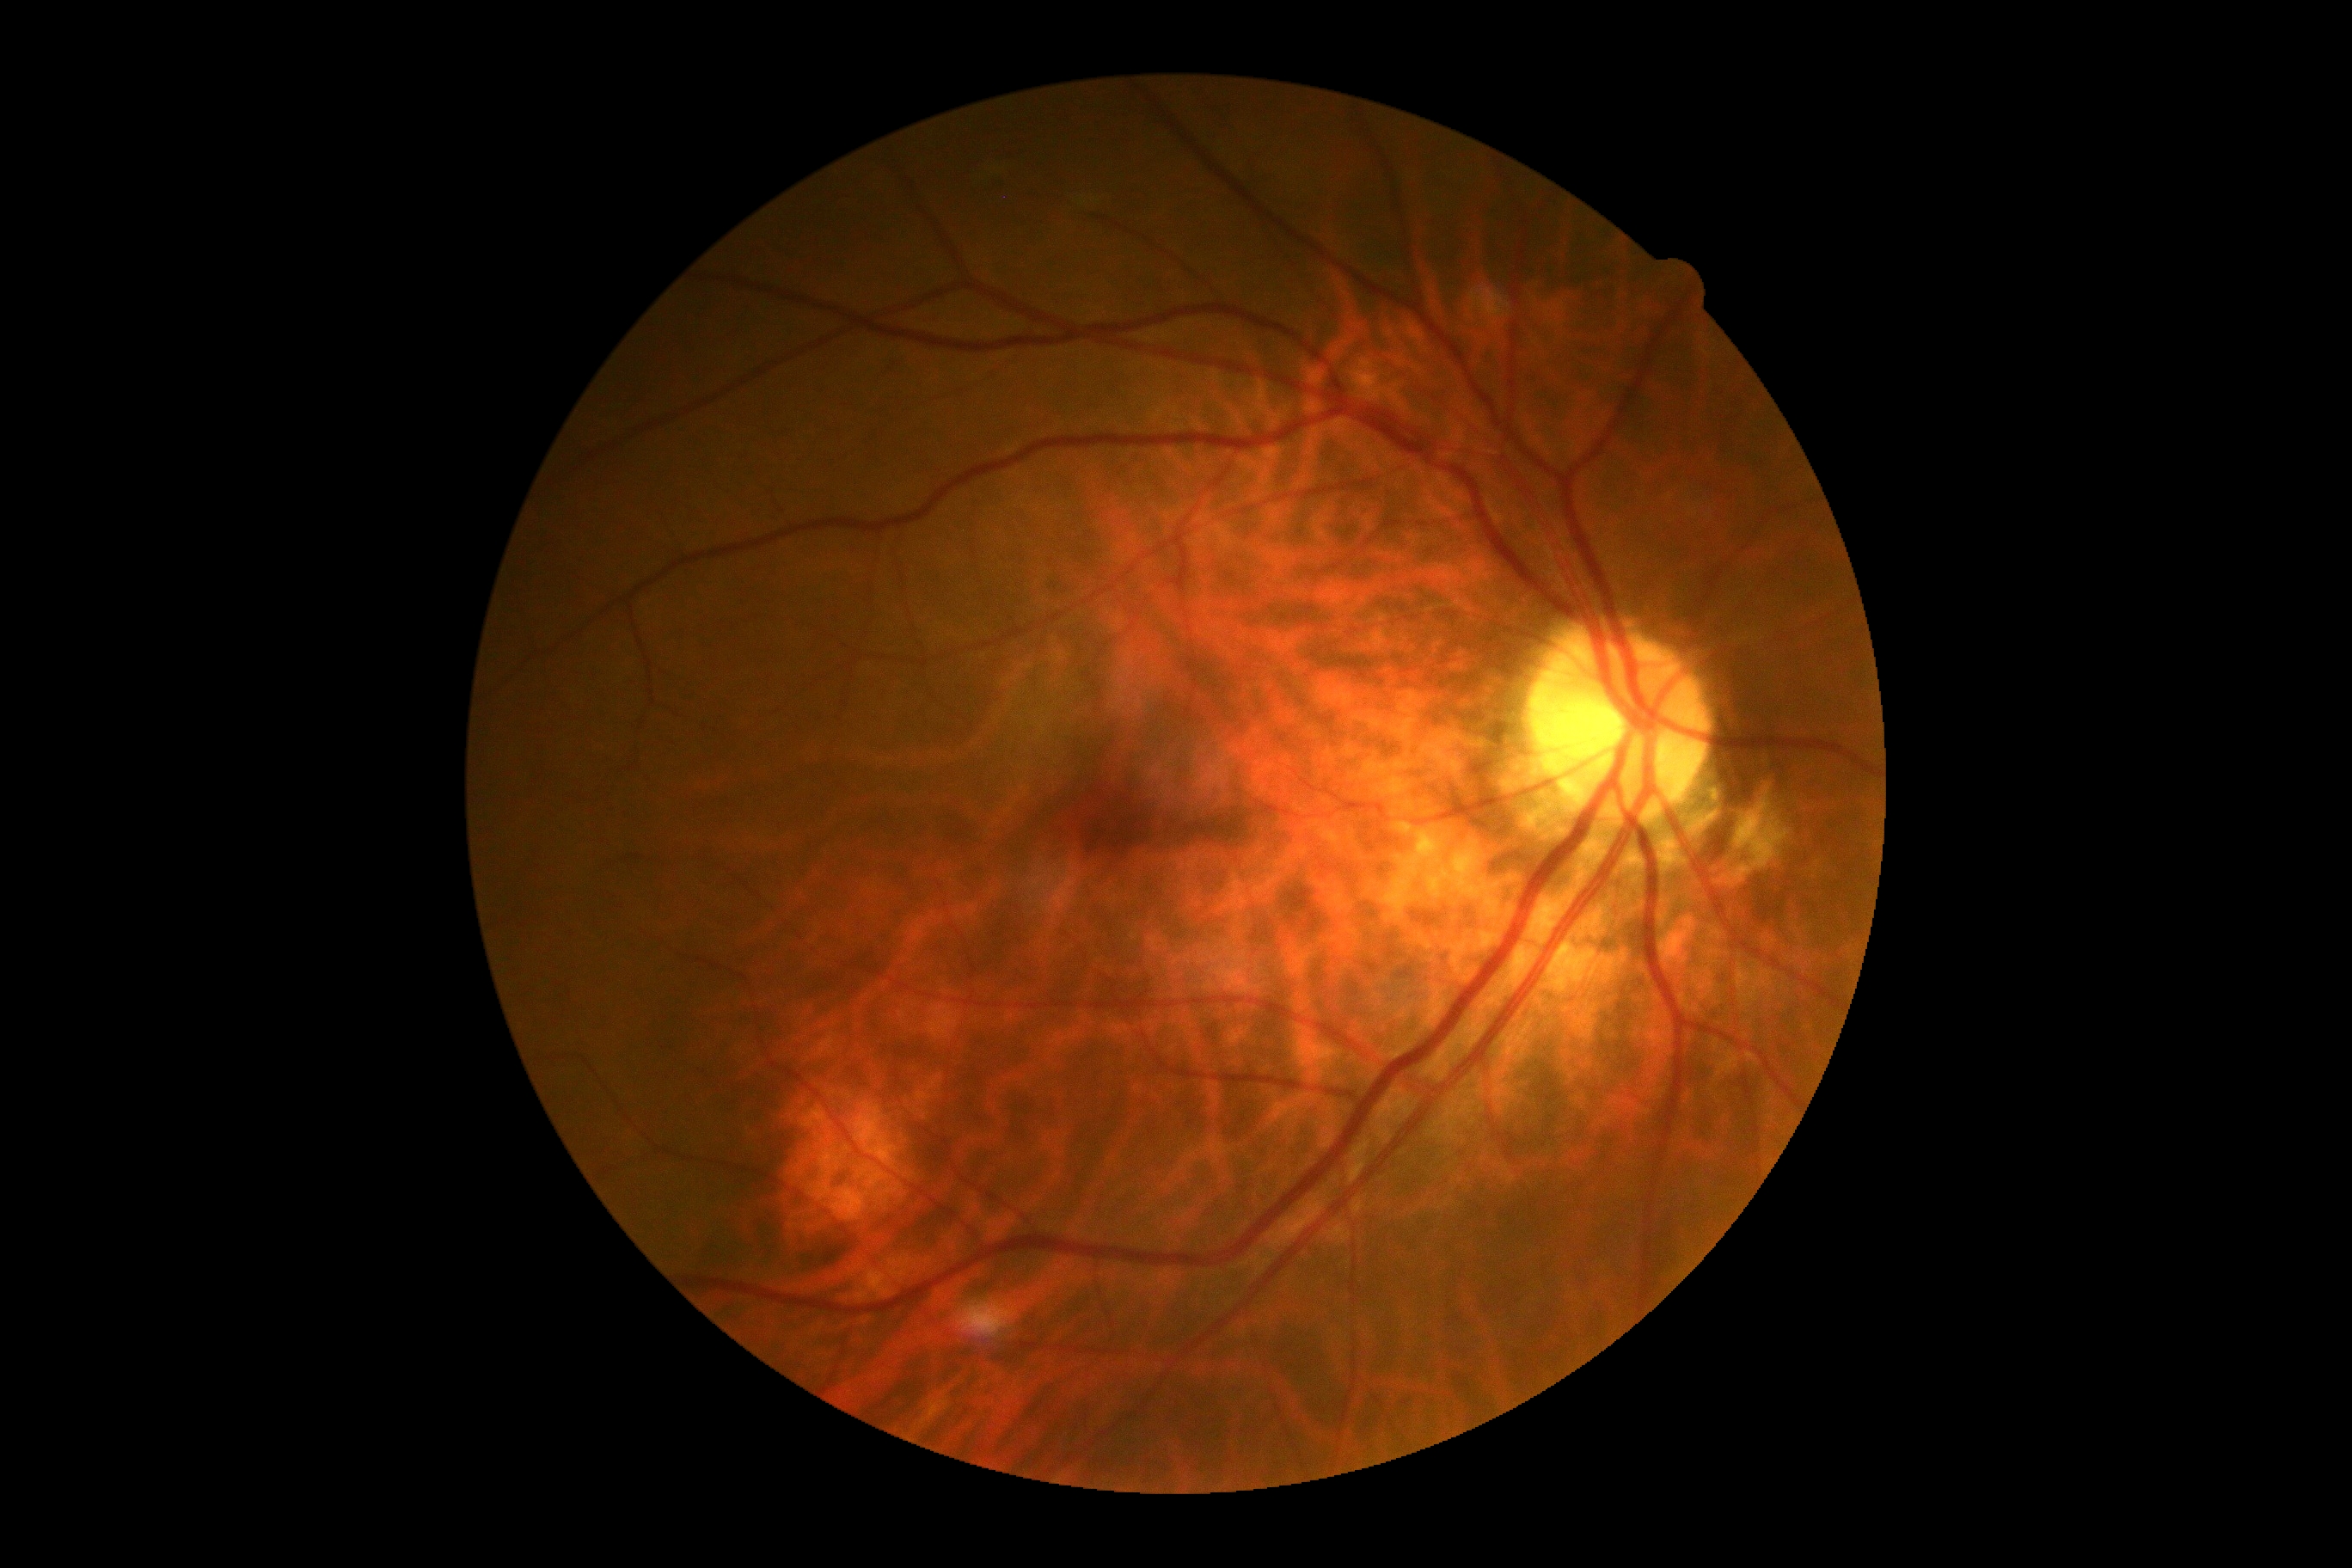 DR grade is 0 (no apparent retinopathy).